Camera: Topcon TRC-NW400; color fundus photograph: 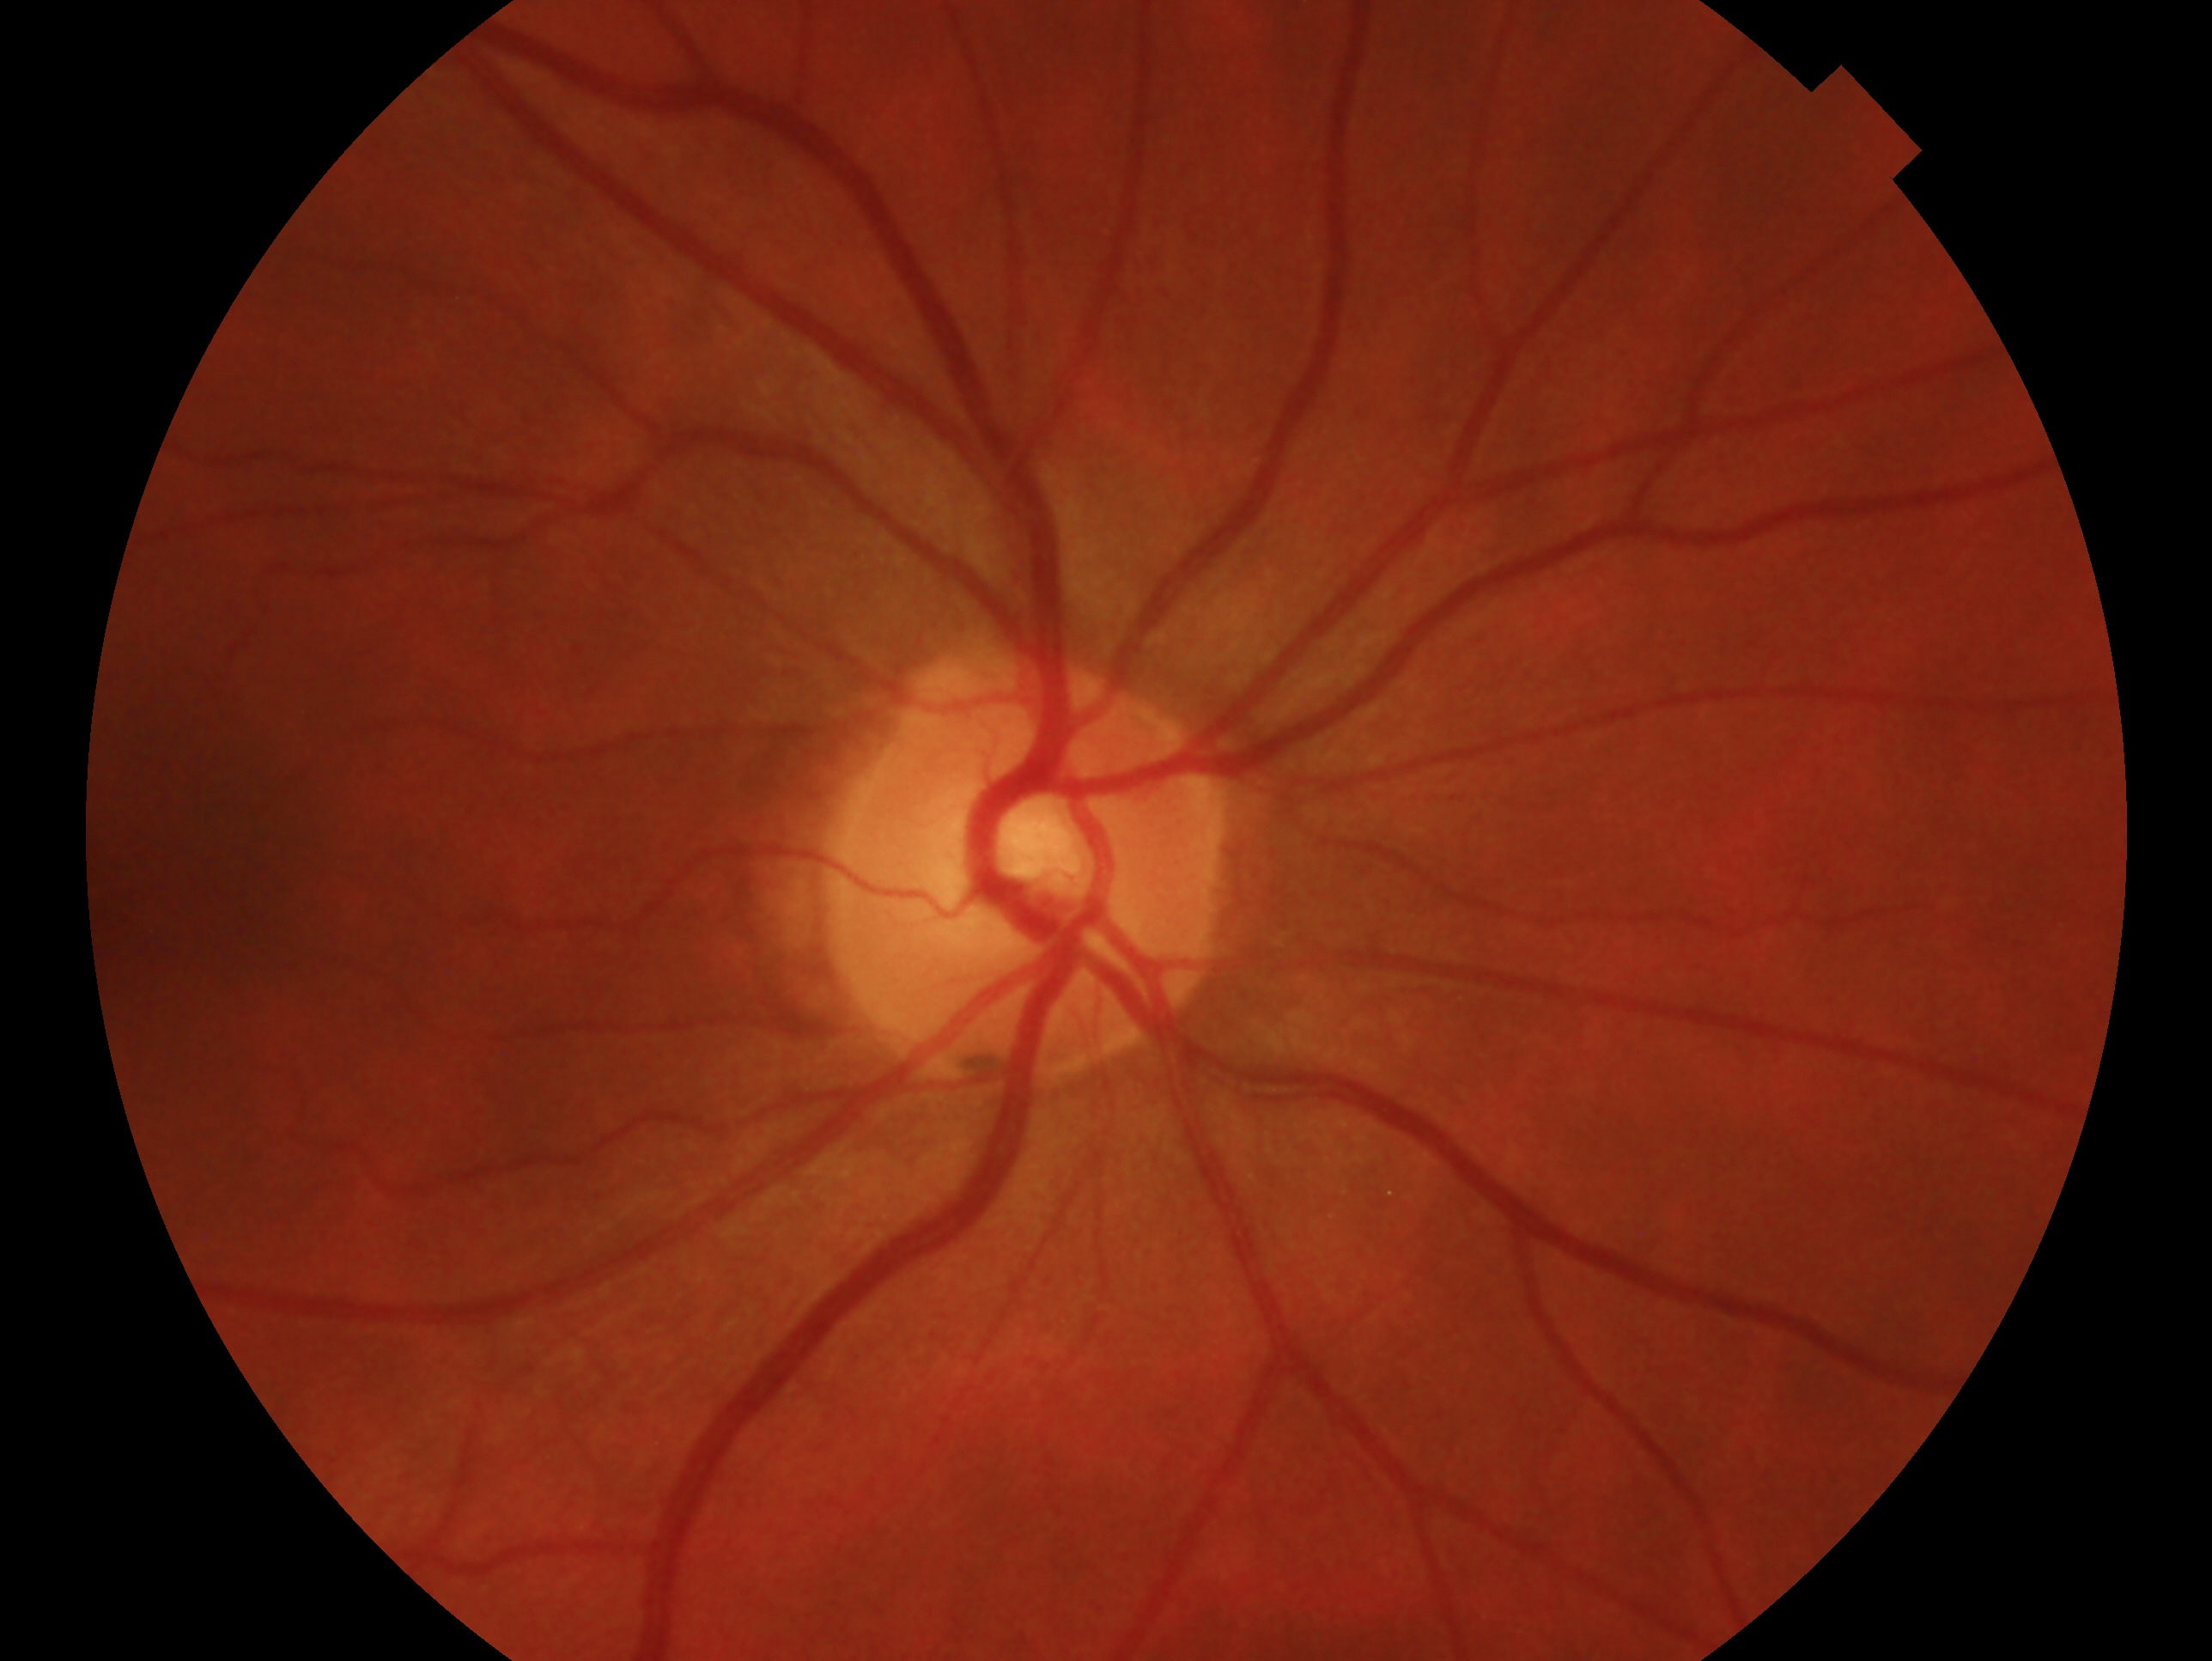
glaucoma diagnosis = no glaucoma
laterality = oculus dexter